FOV: 60 degrees · image size 2212x1659:
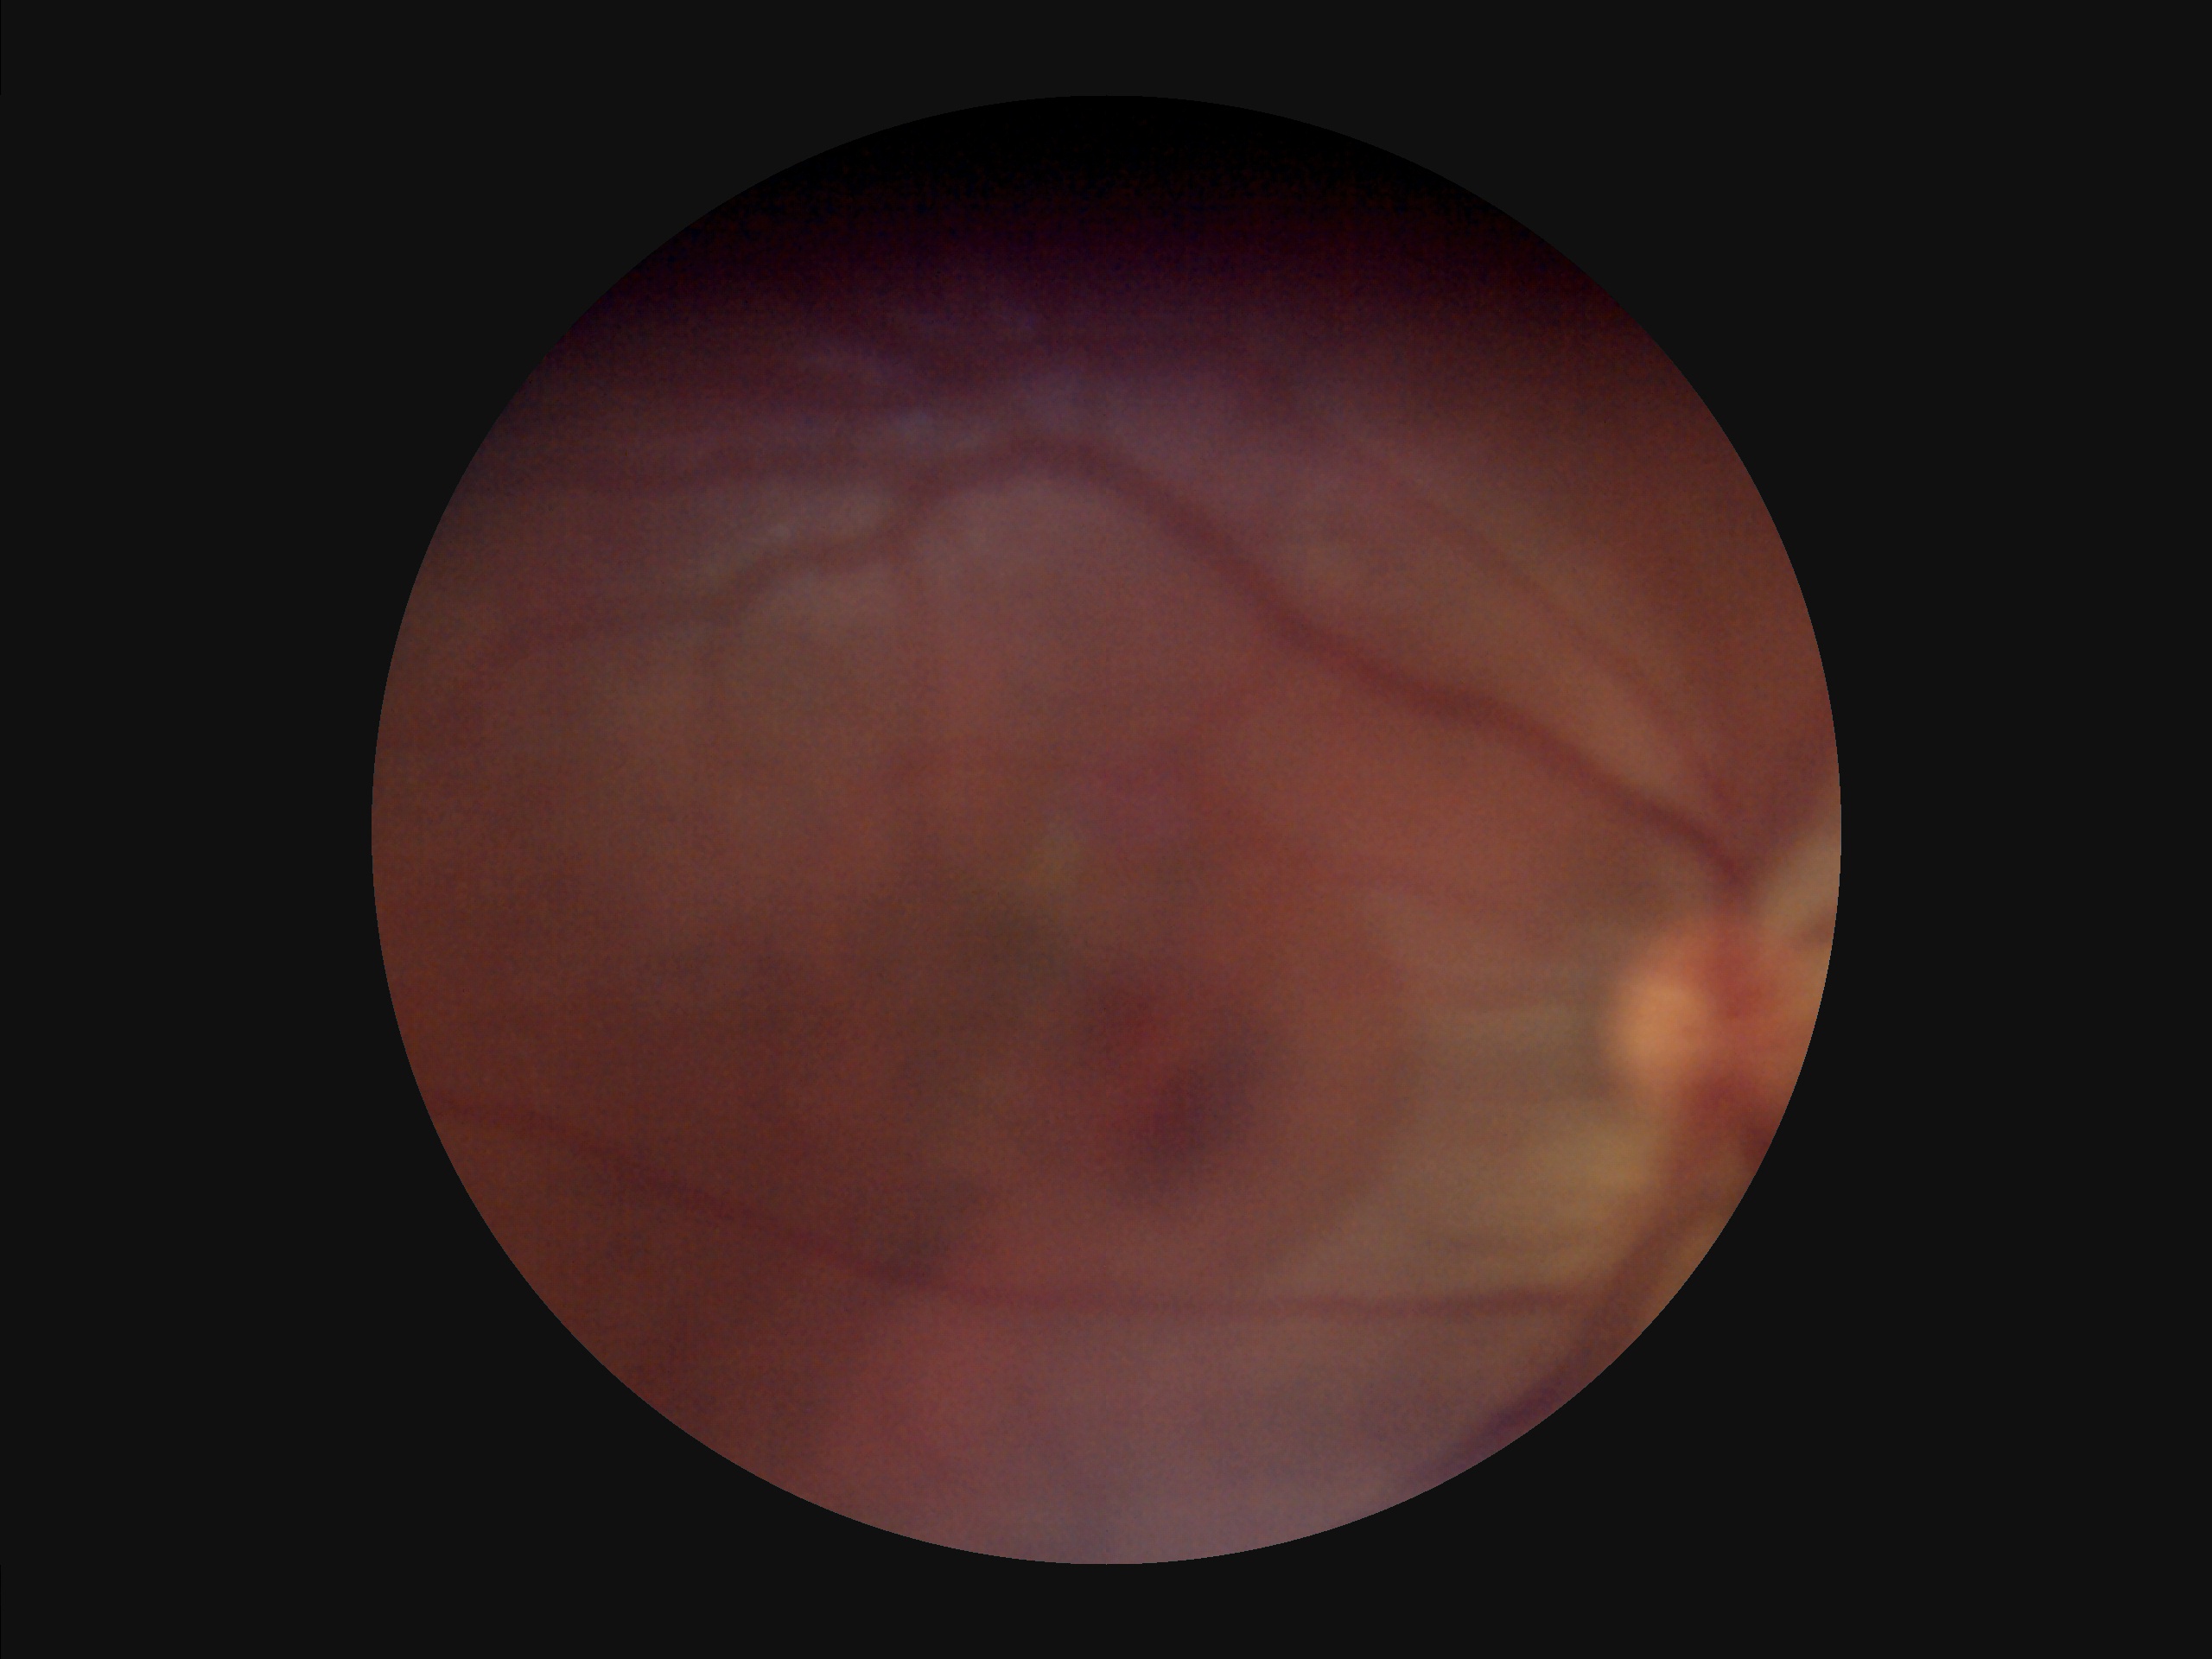

Vessels and details are hard to distinguish.
Reduced sharpness with visible blur.
Poor illumination with uneven exposure.
Overall quality is poor; the image is difficult to grade.